Captured after pupil dilation; camera: Topcon TRC-50DX; 50° FOV:
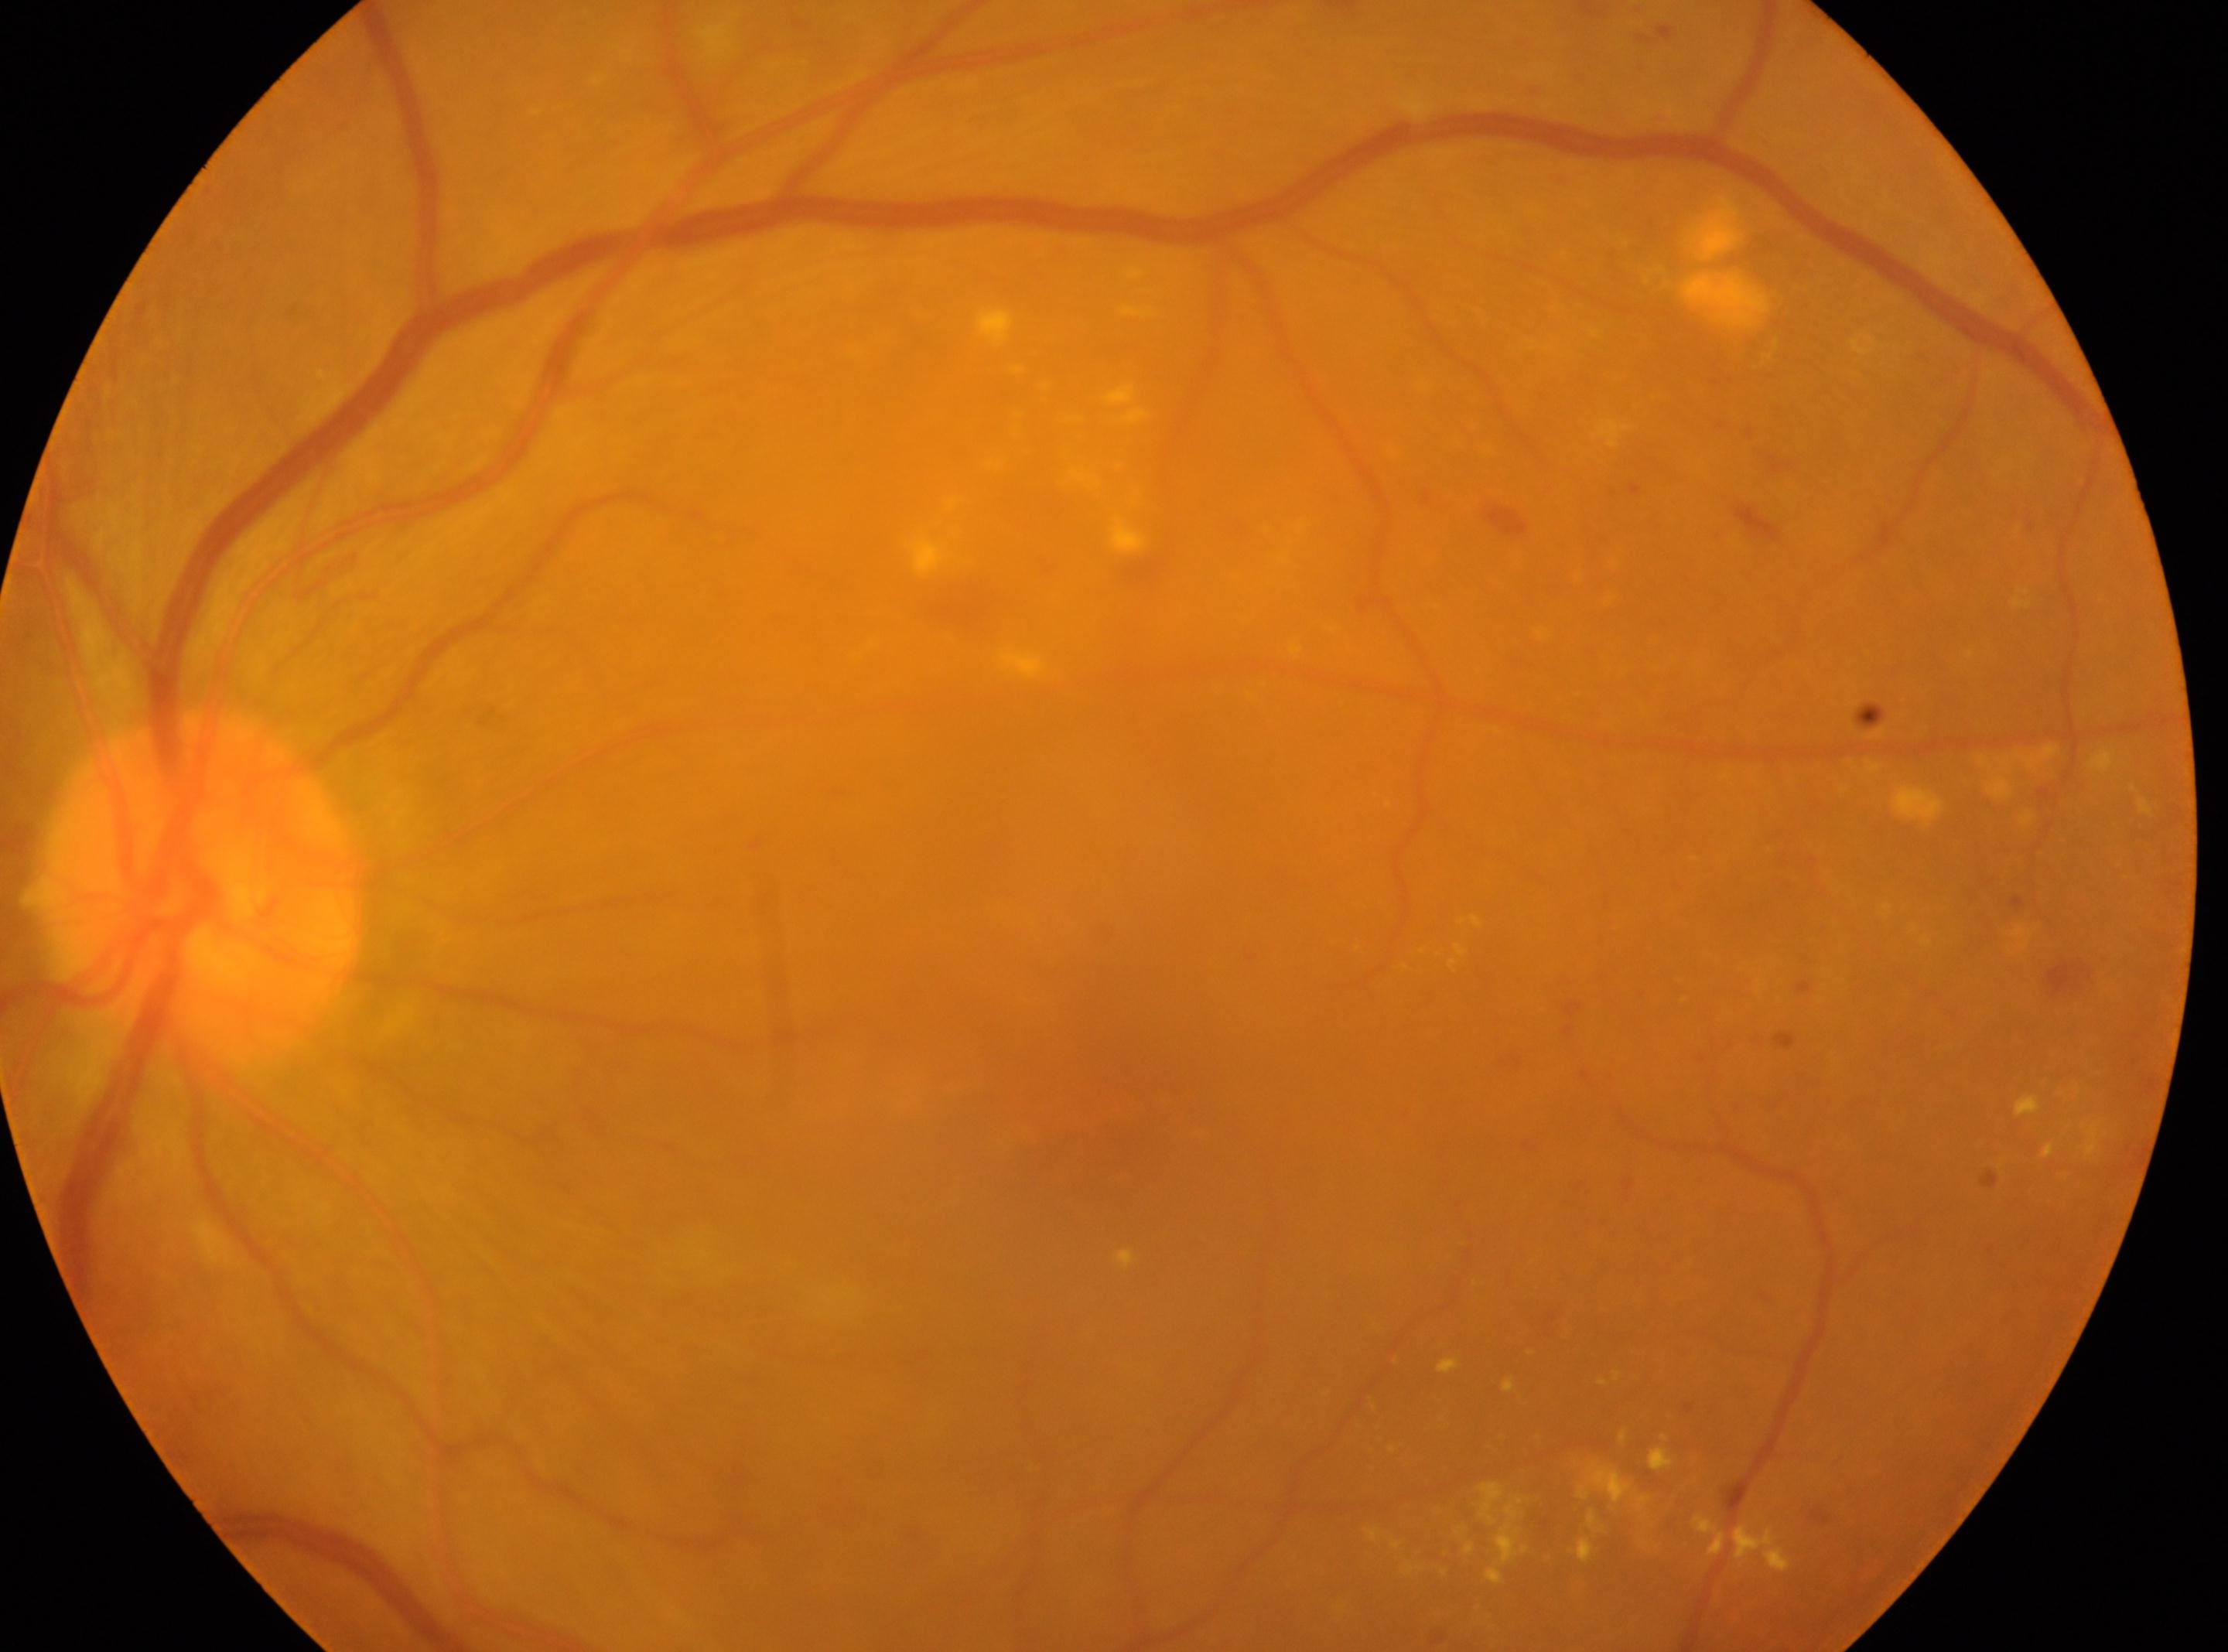

Disc center: (198,889). This is the left eye. DR severity: grade 2 (moderate NPDR). Fovea located at (1094,1103).